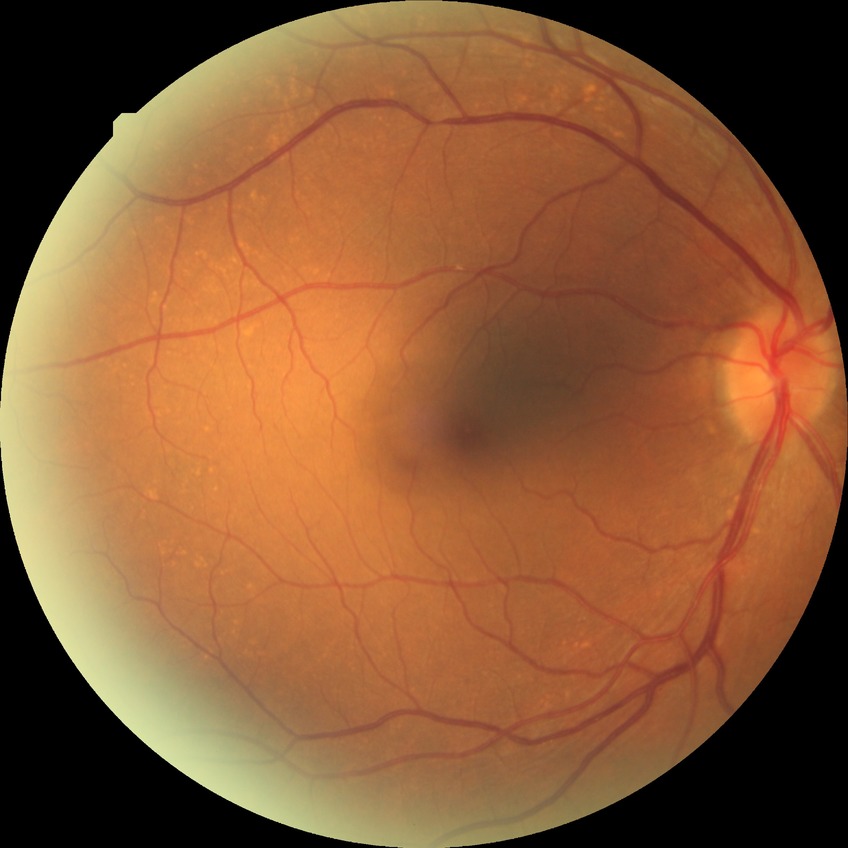 Findings:
• modified Davis grading — no diabetic retinopathy